Graded on the modified Davis scale: 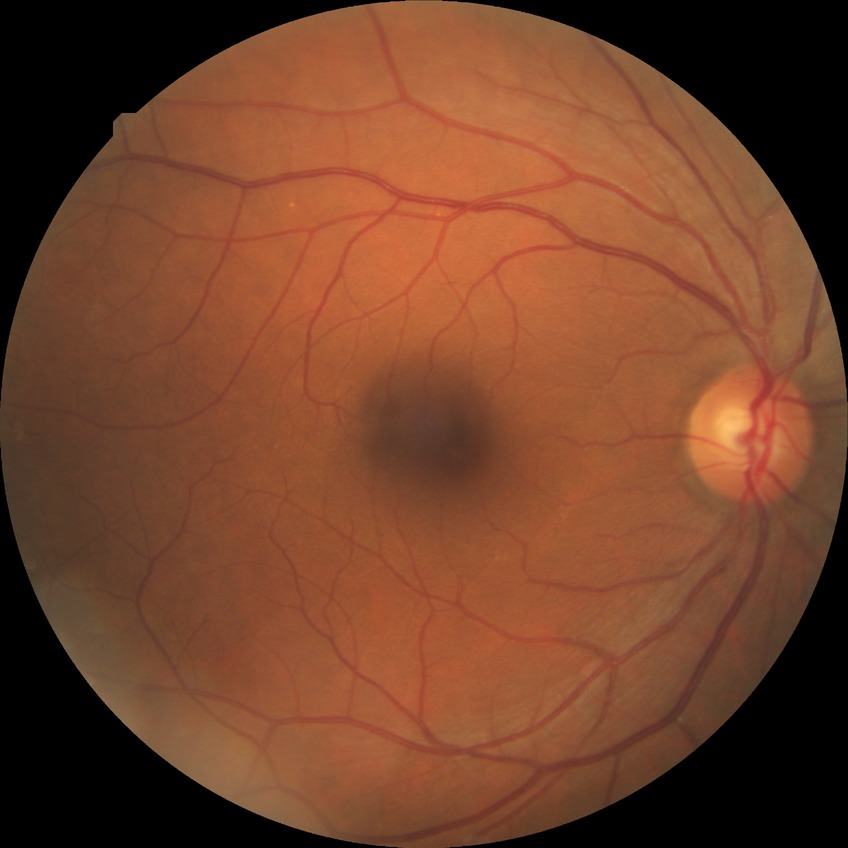 modified Davis grading: no diabetic retinopathy